2352 by 1568 pixels:
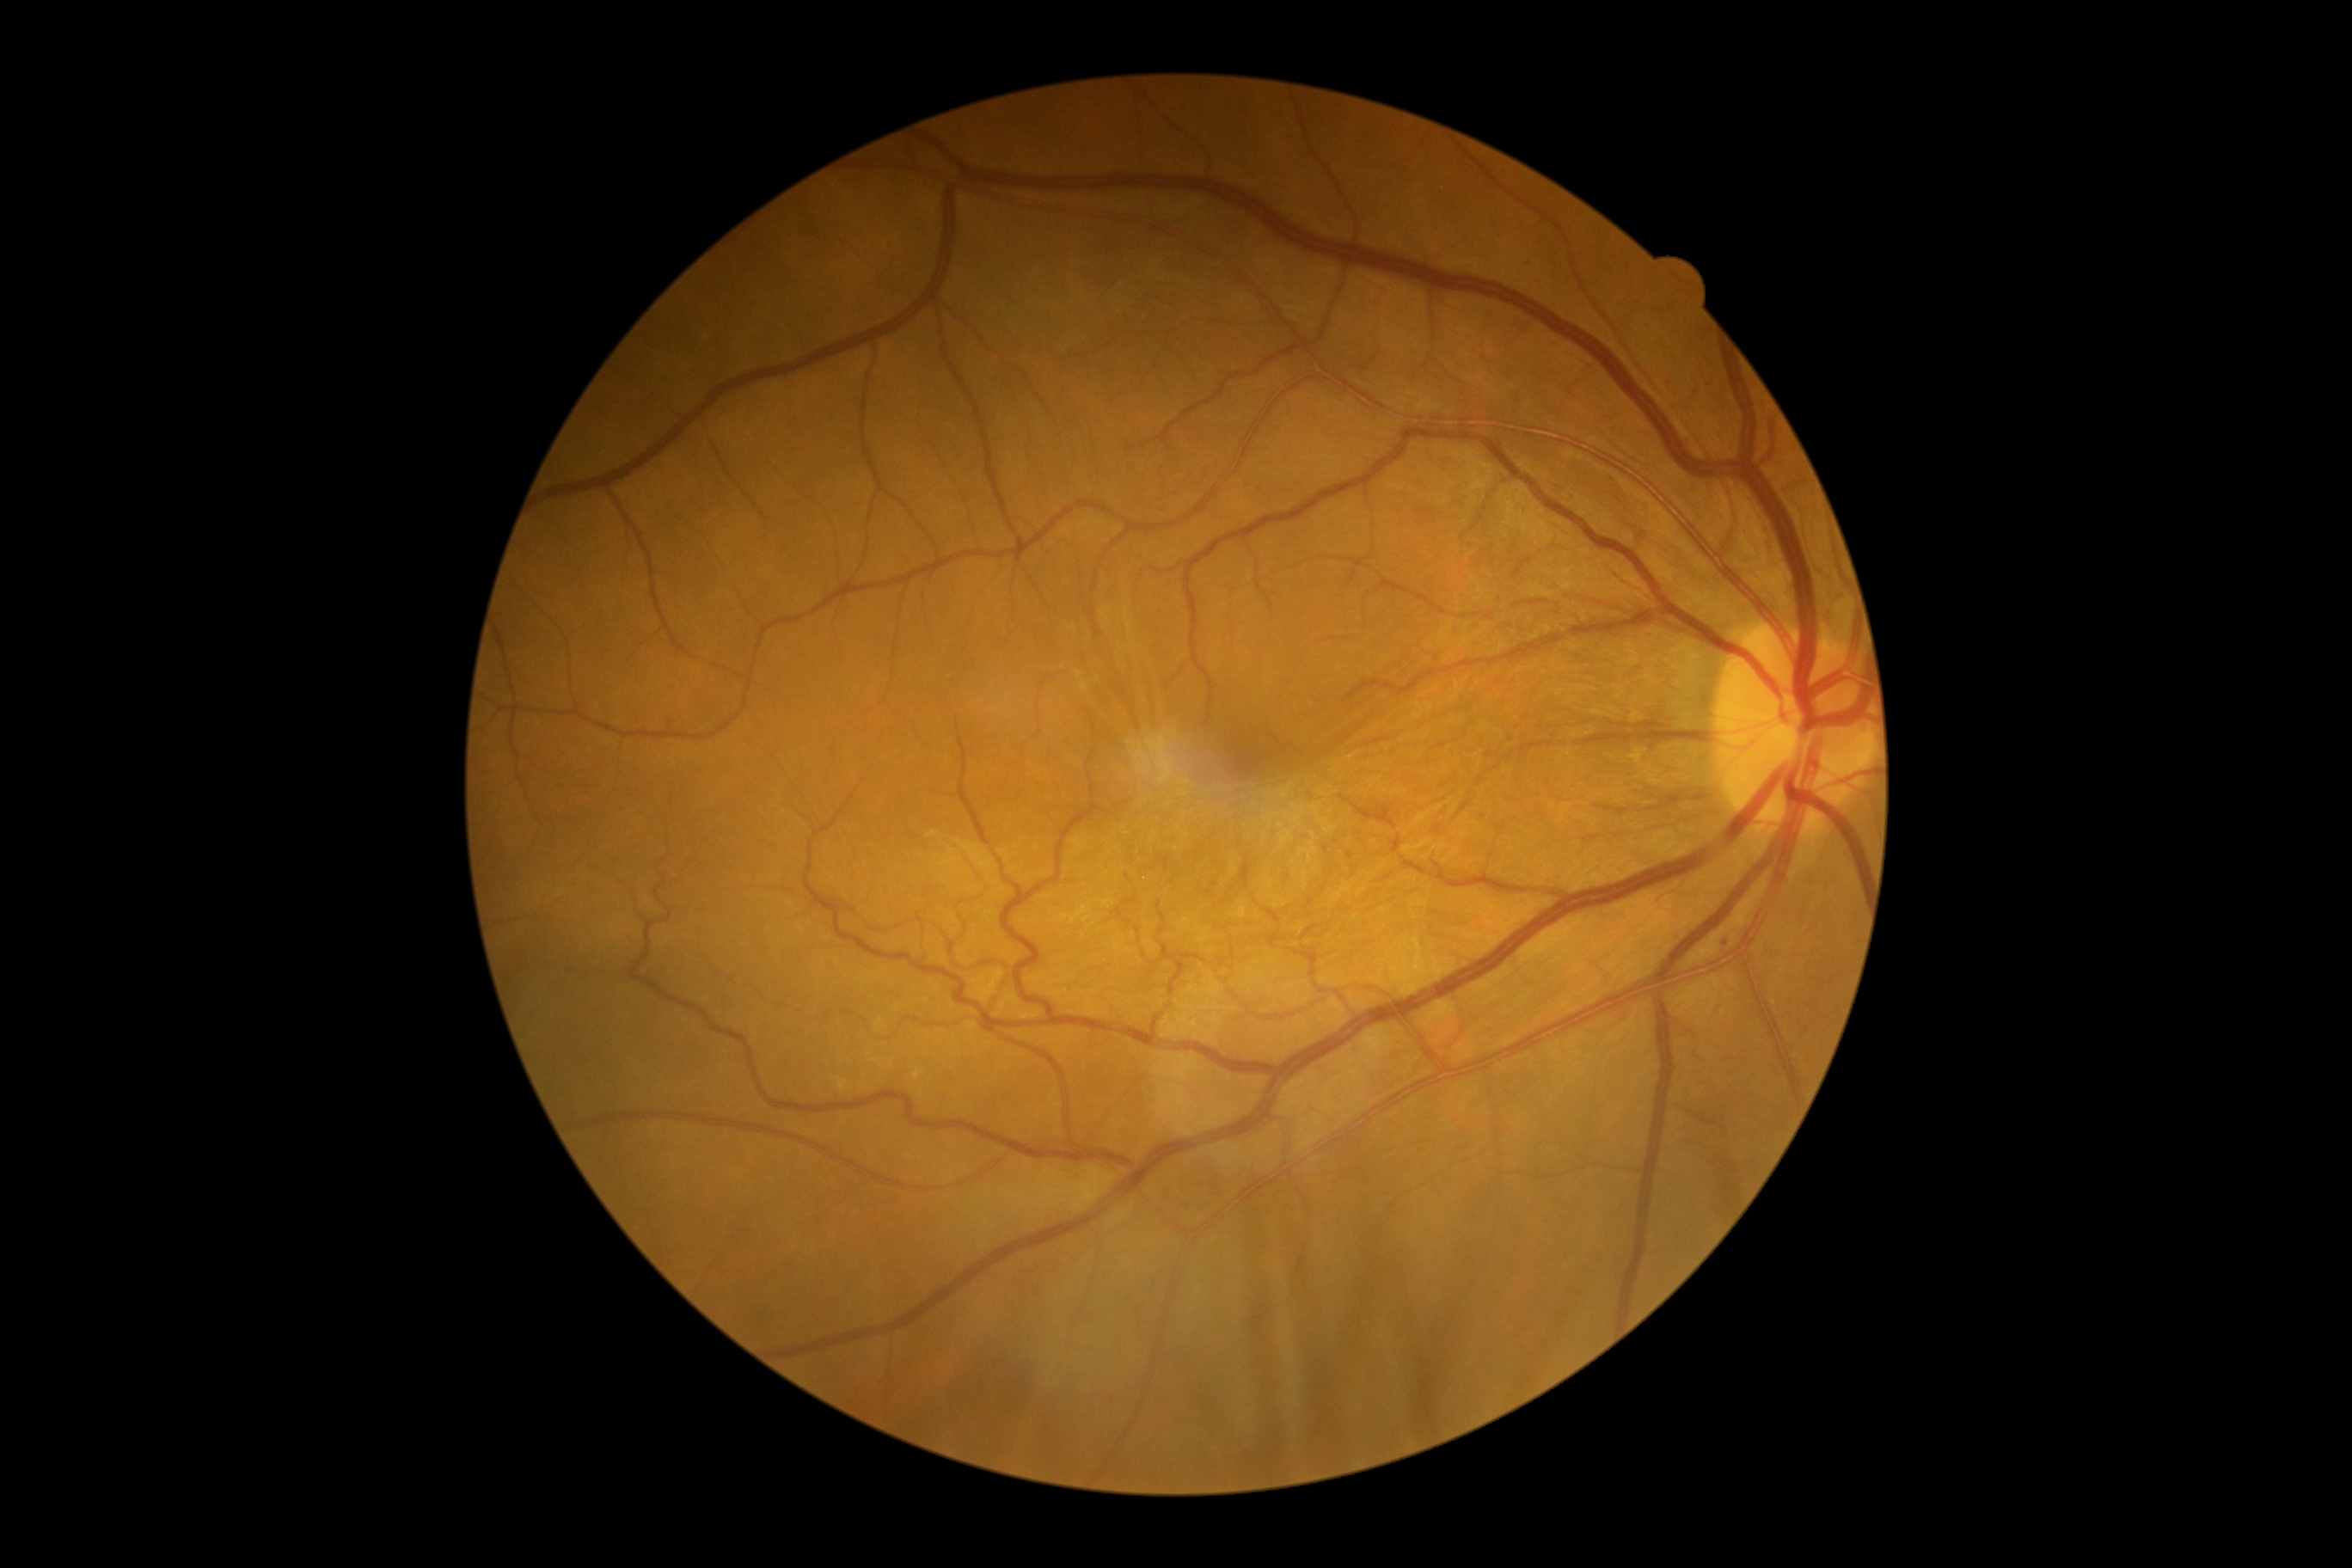
DR class=non-proliferative diabetic retinopathy; diabetic retinopathy severity=grade 1 (mild NPDR).